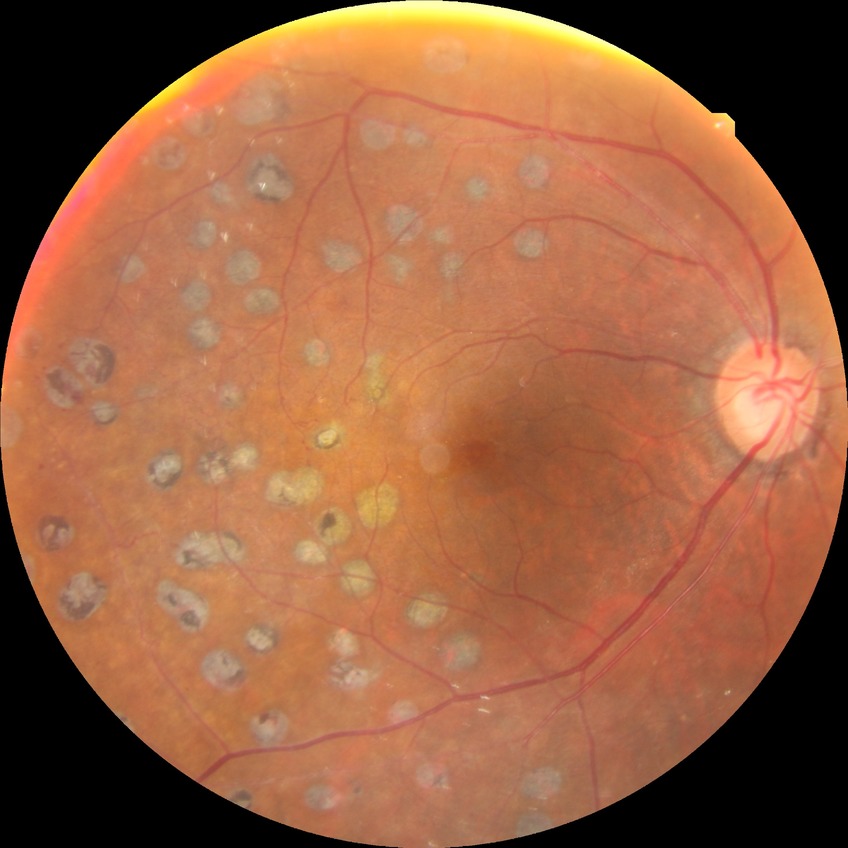

diabetic retinopathy (DR) = PDR (proliferative diabetic retinopathy).